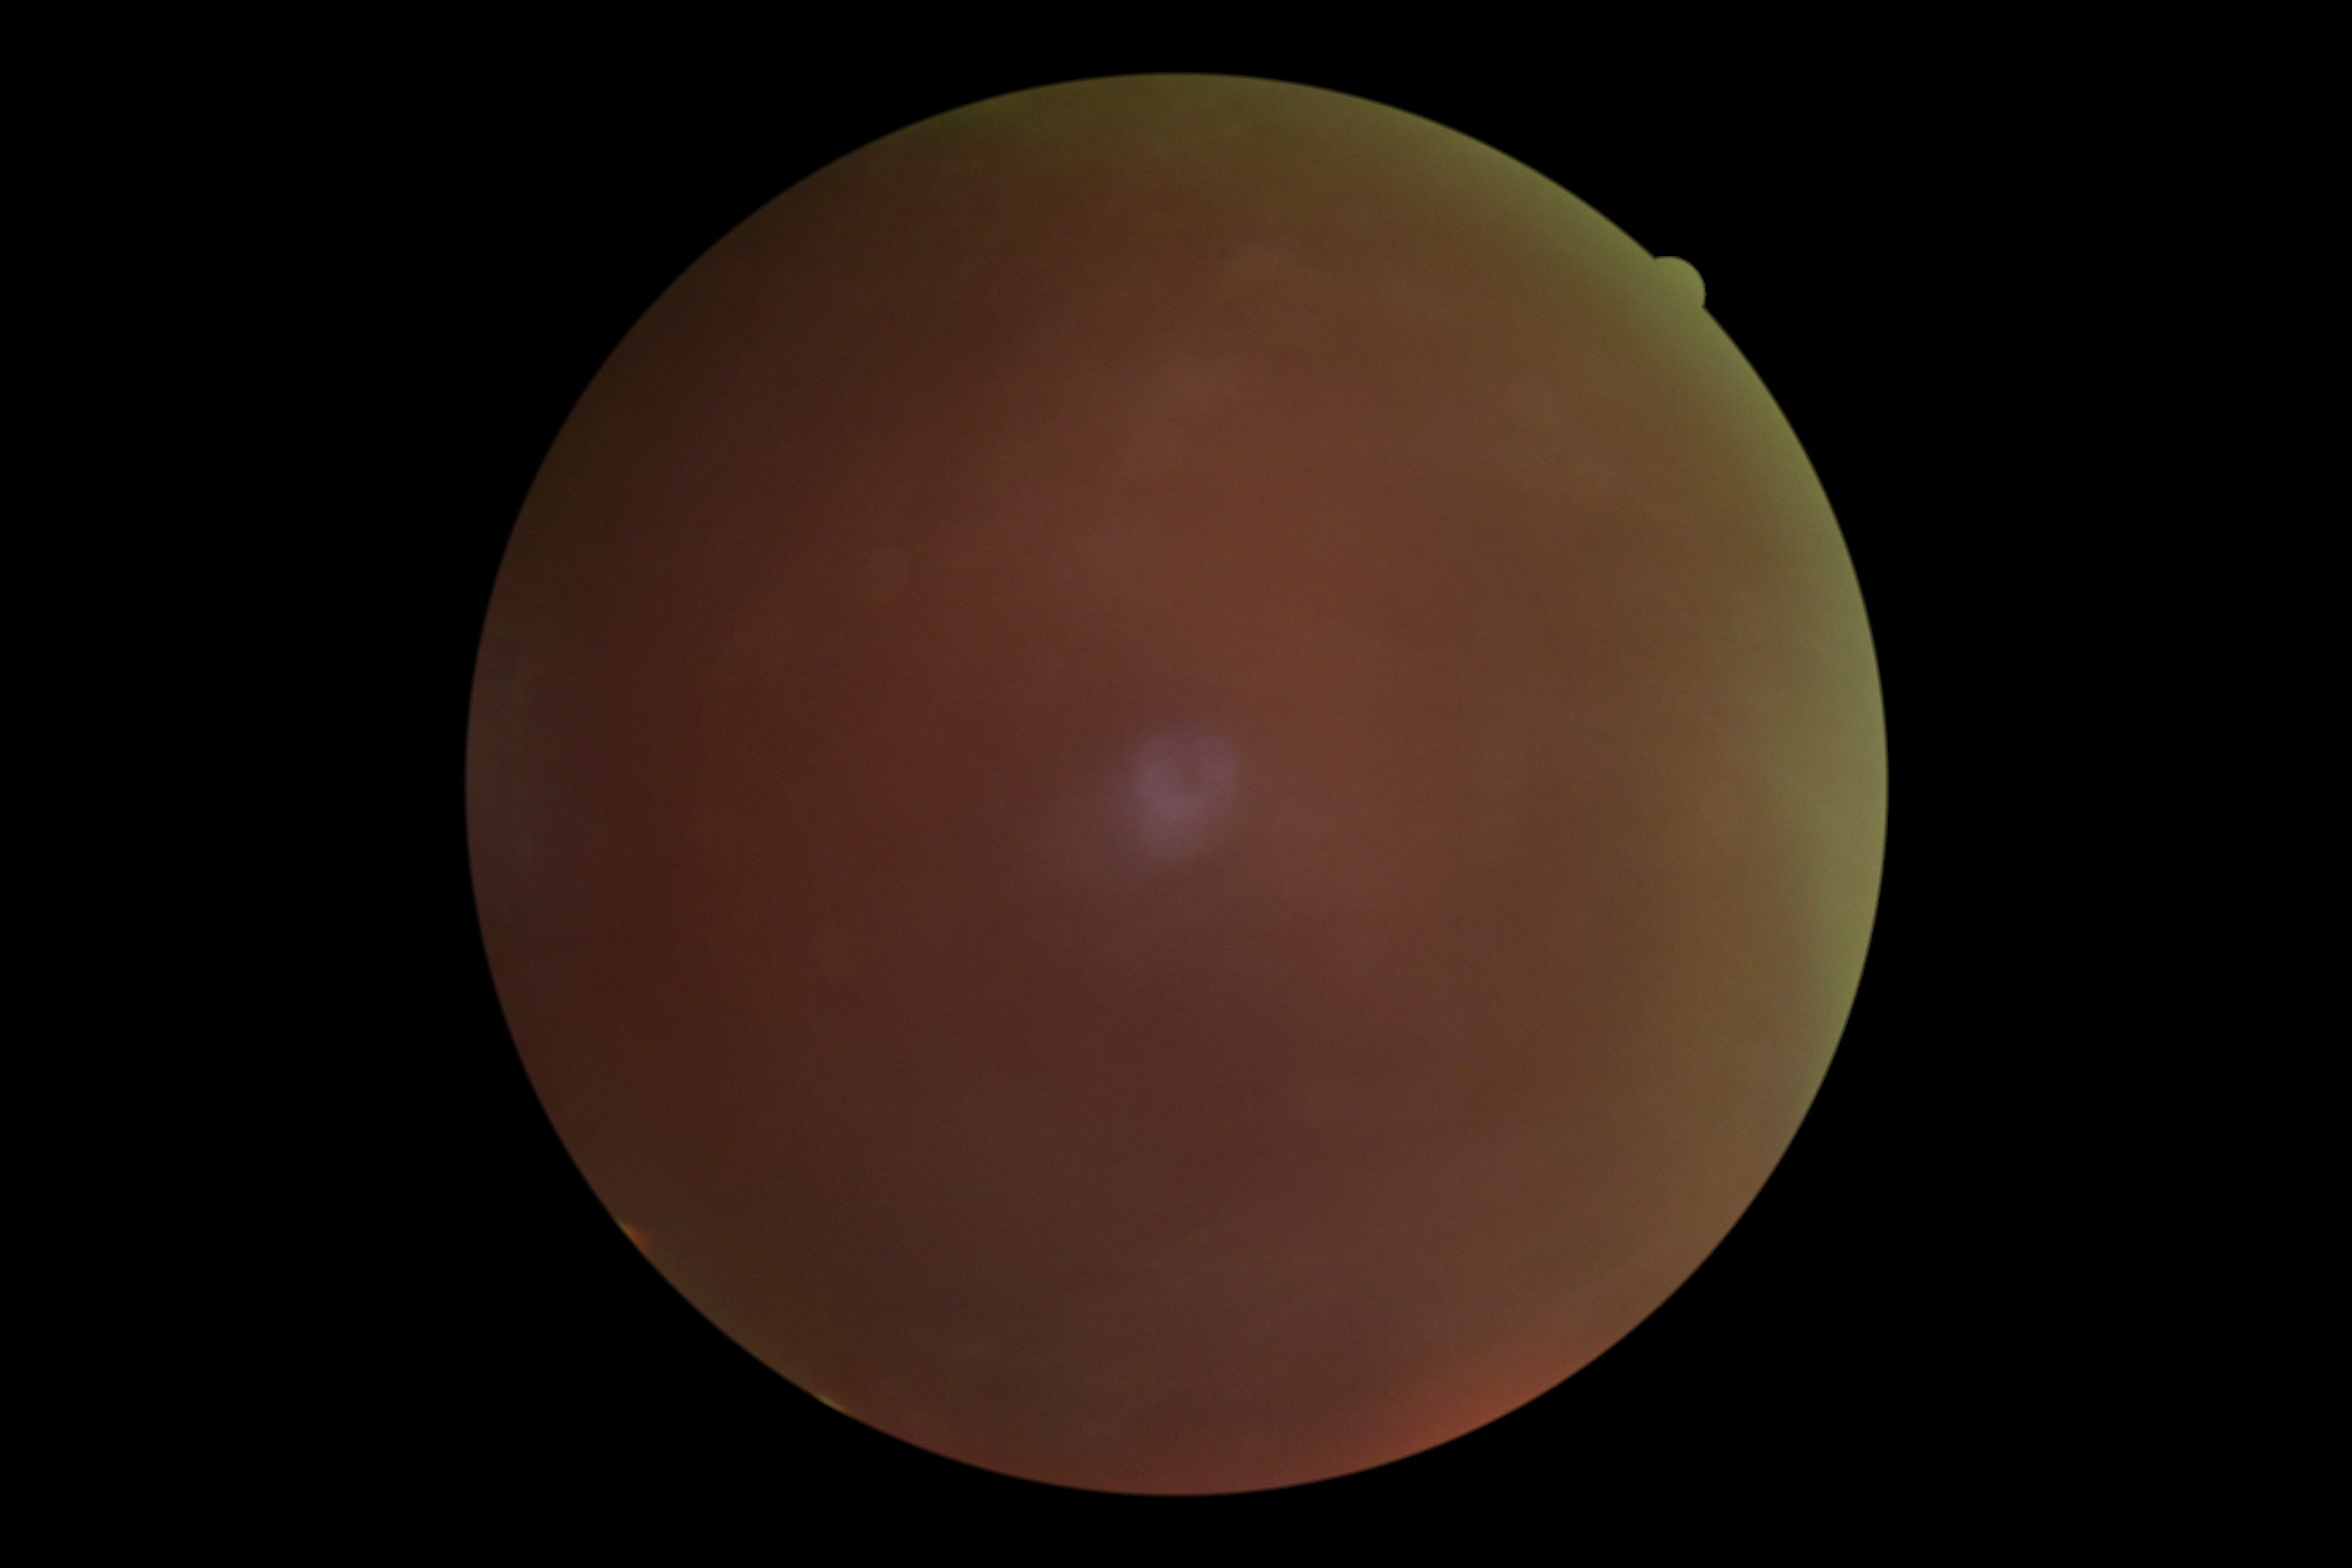

DR: ungradable.